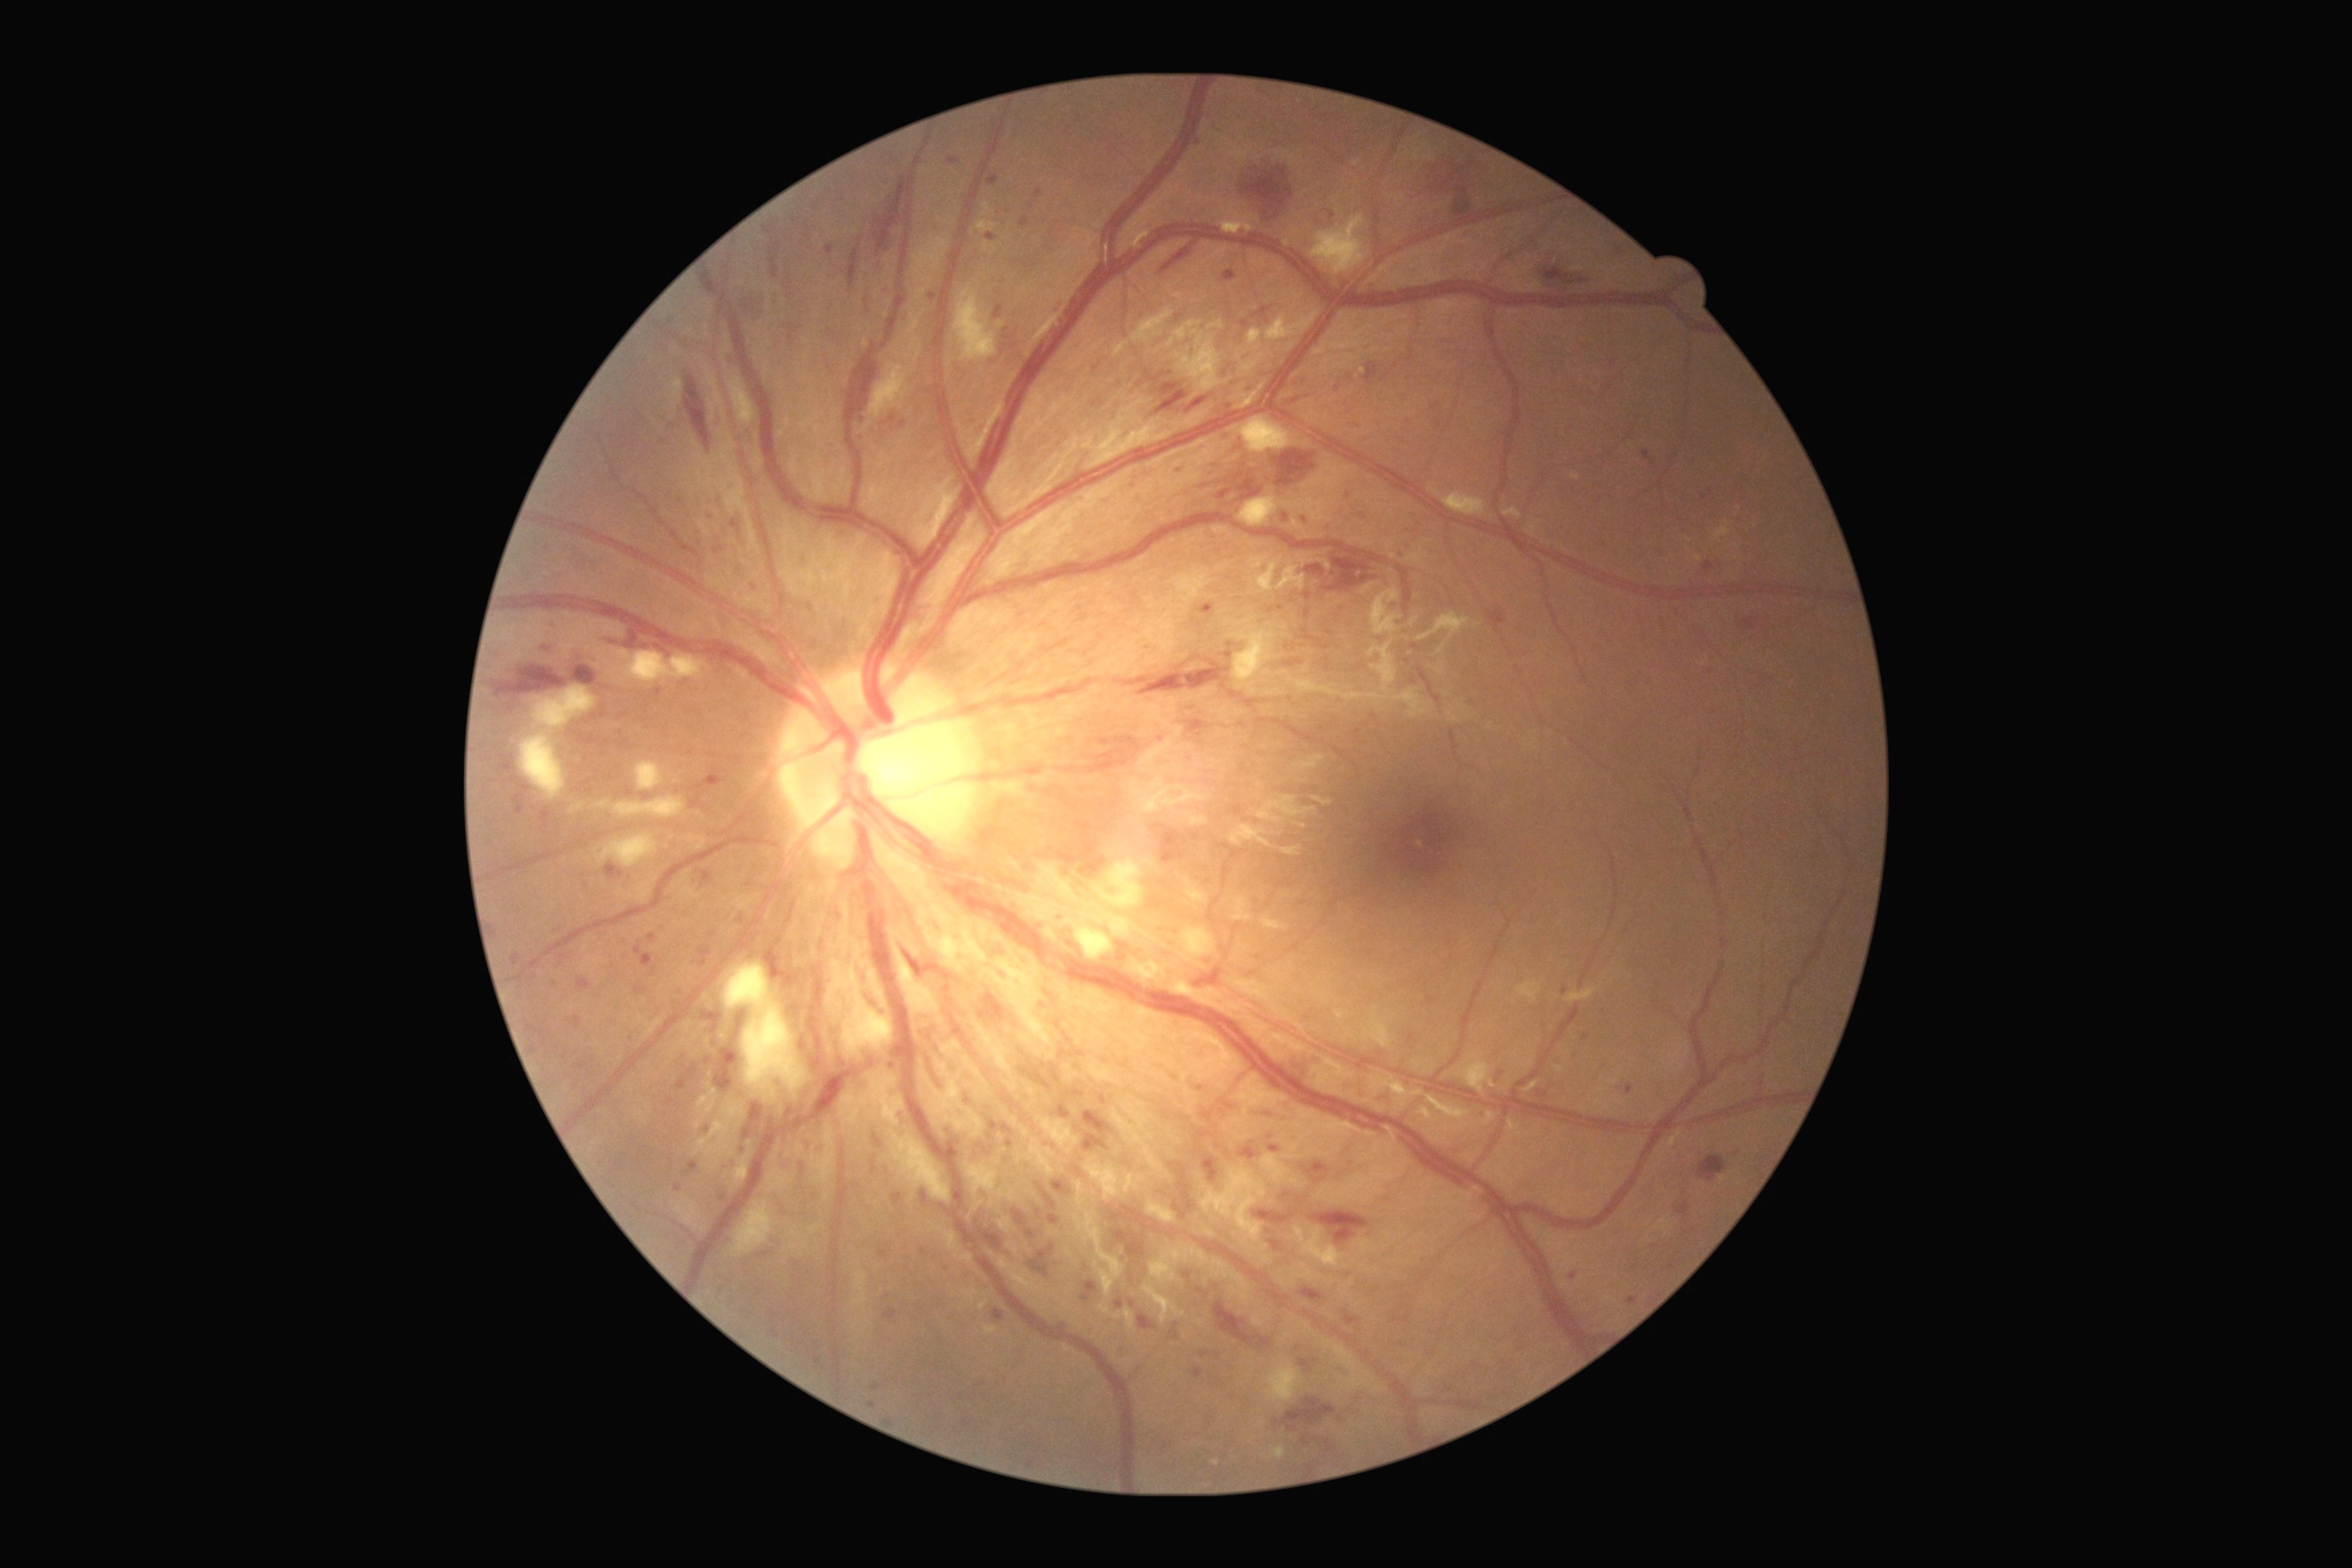
DR stage is grade 3
Lesions identified (partial list):
- MAs (subset): bbox=[1057, 1324, 1068, 1329], bbox=[1052, 1181, 1068, 1195], bbox=[1538, 1090, 1547, 1099], bbox=[1003, 1124, 1014, 1135], bbox=[1200, 1112, 1213, 1122], bbox=[1676, 1204, 1690, 1217], bbox=[1231, 807, 1242, 816], bbox=[1231, 380, 1239, 387], bbox=[787, 1108, 794, 1117], bbox=[1284, 514, 1289, 522], bbox=[1081, 1280, 1097, 1304]
- Small MAs near (711, 935), (554, 984), (735, 487), (671, 321), (968, 1100), (1586, 1038), (1125, 946)